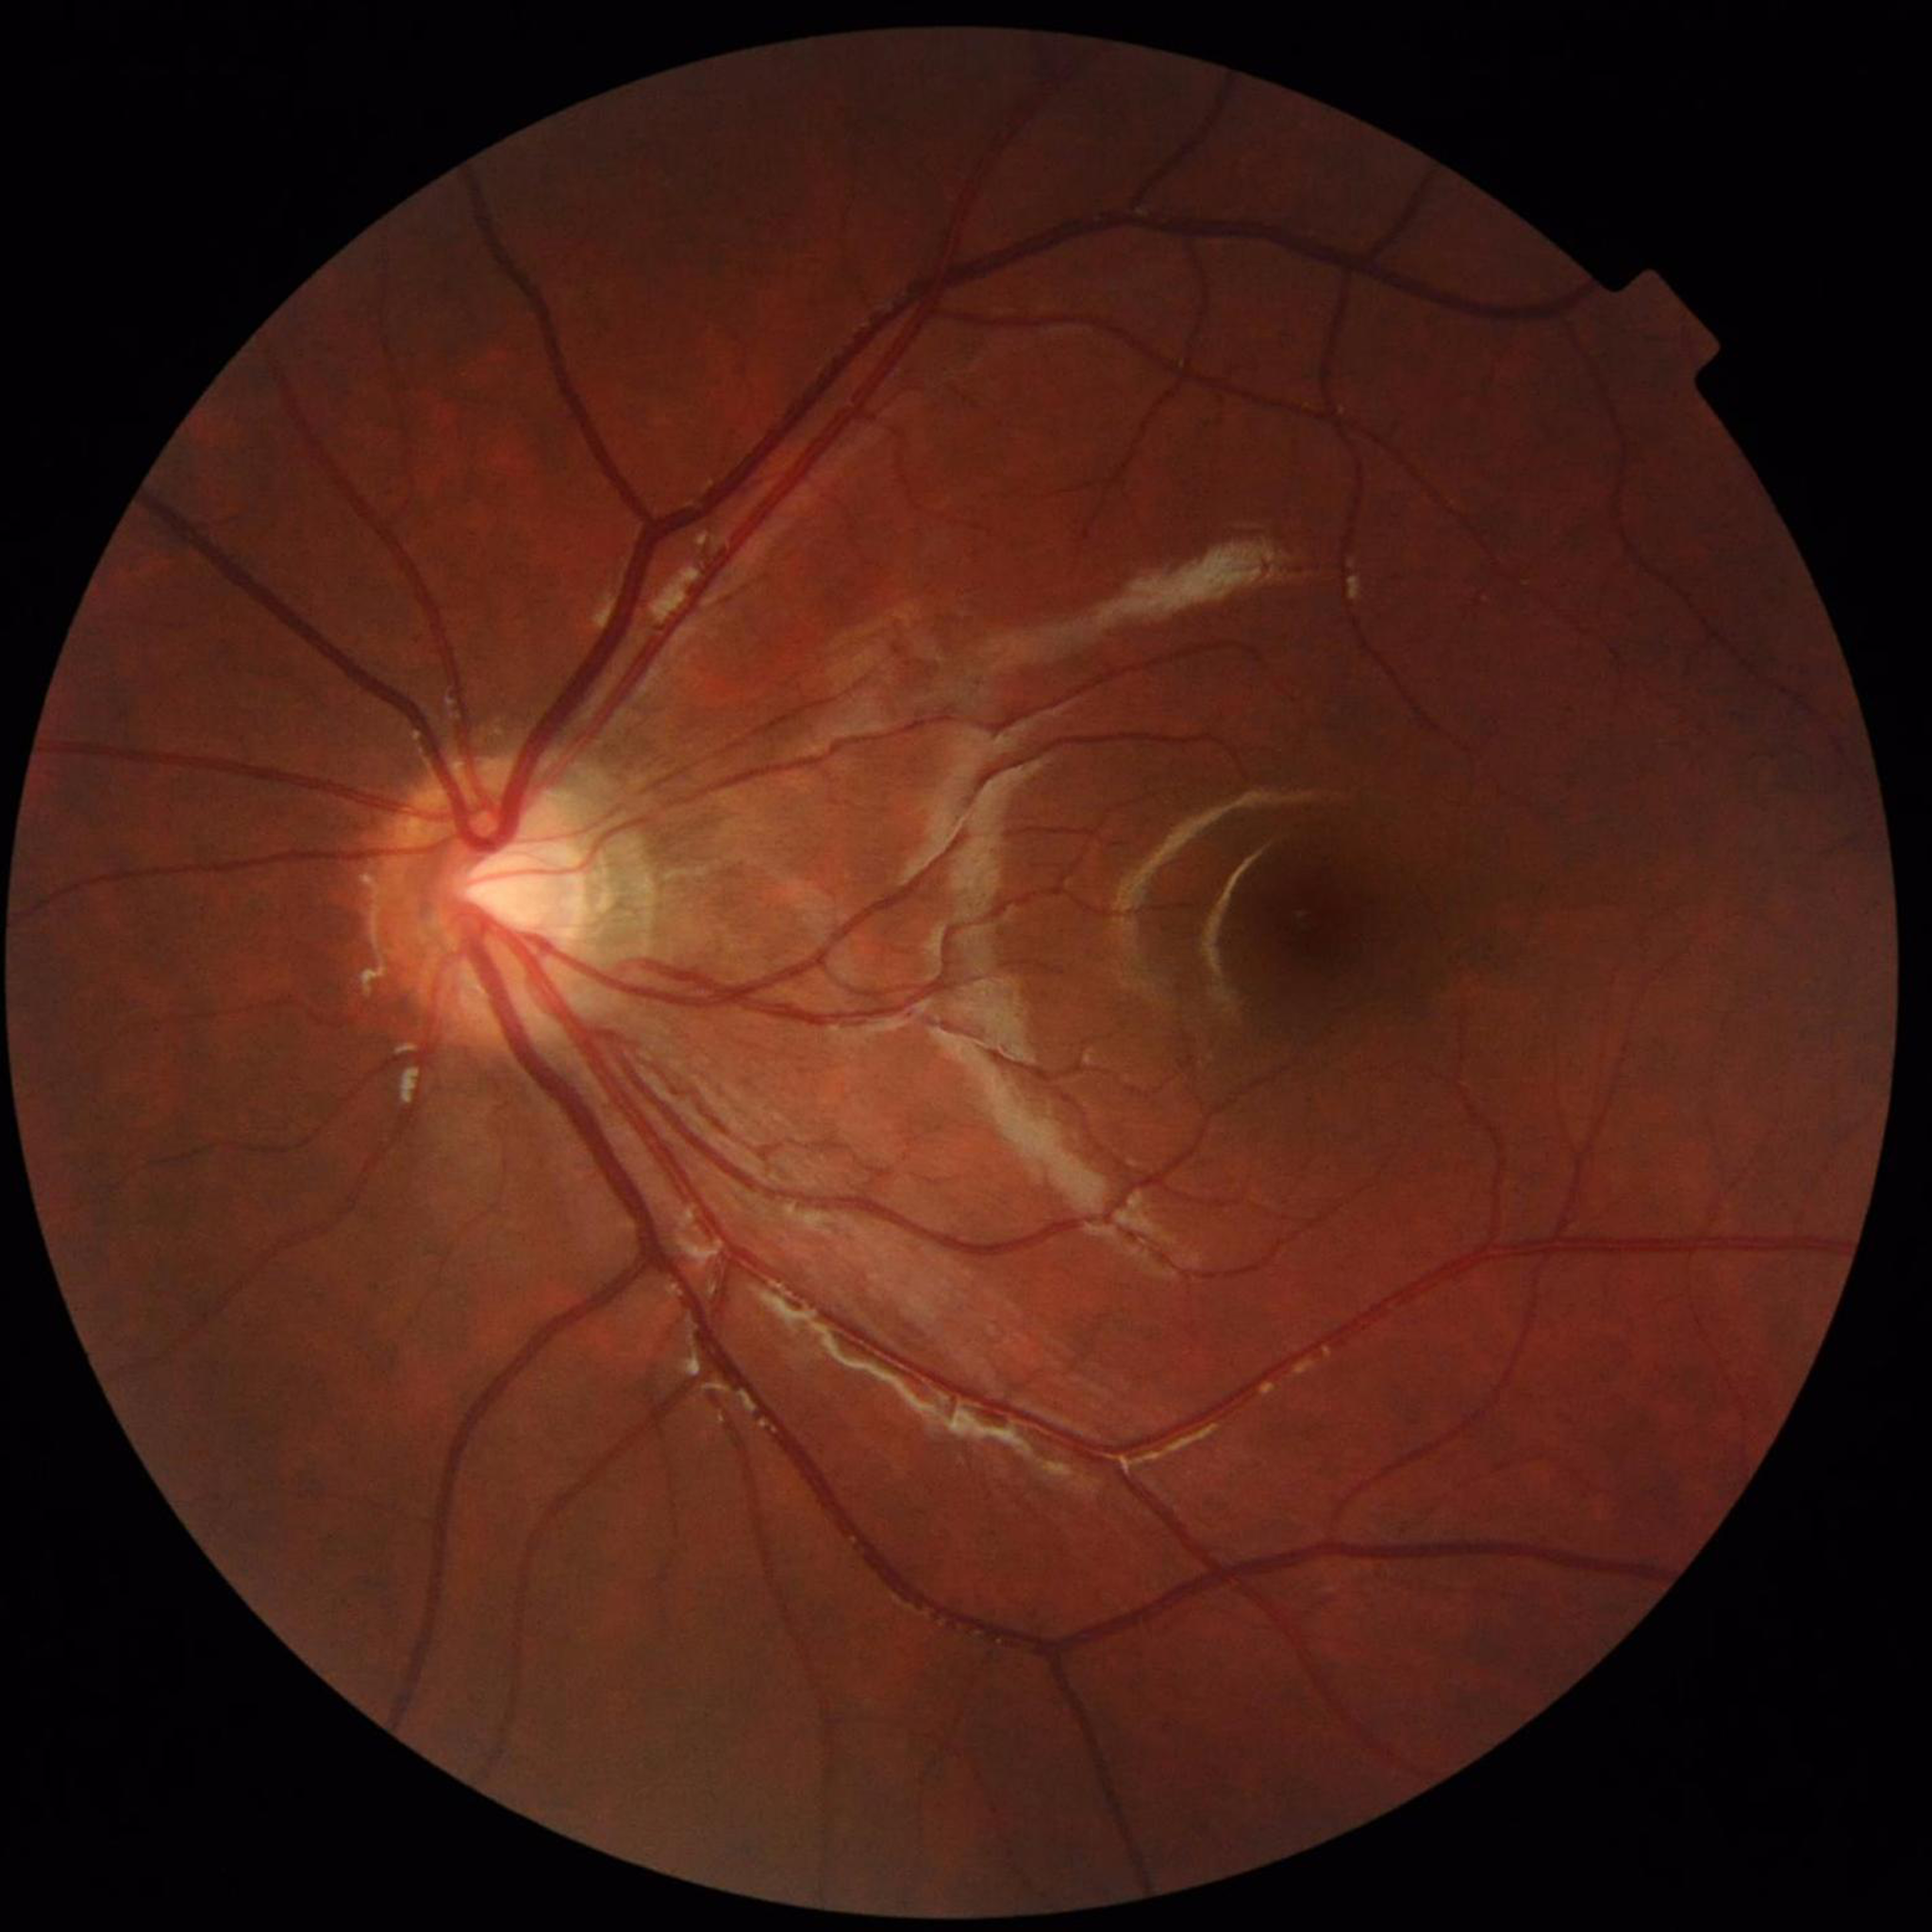
No findings of AMD, diabetic retinopathy, or glaucoma.